848 by 848 pixels:
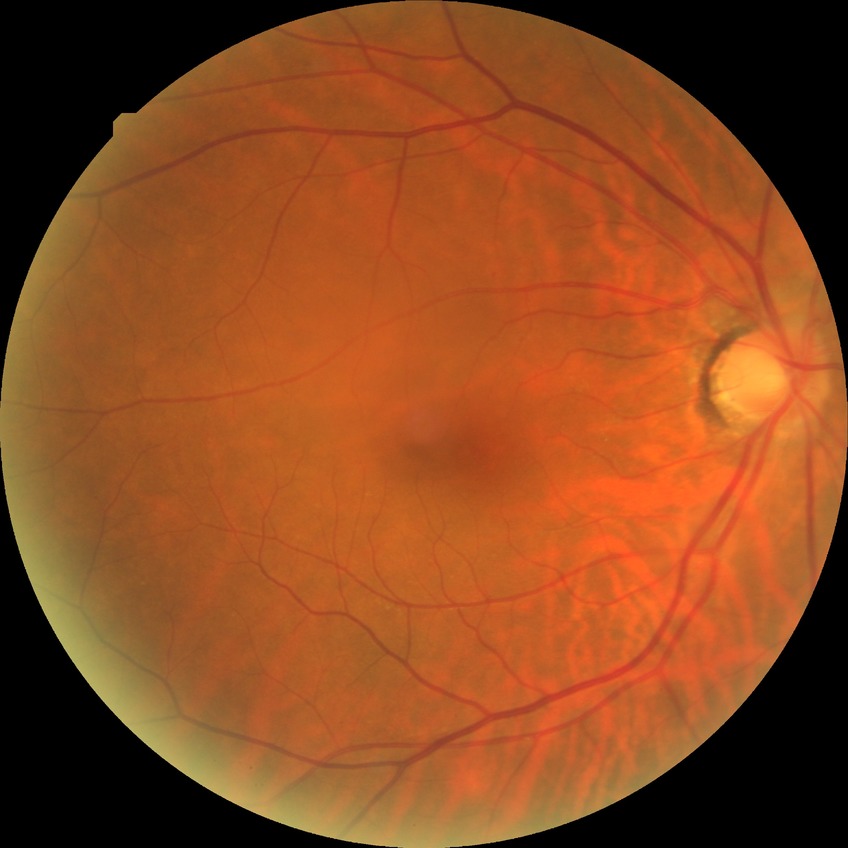
davis_grade: no diabetic retinopathy (NDR)